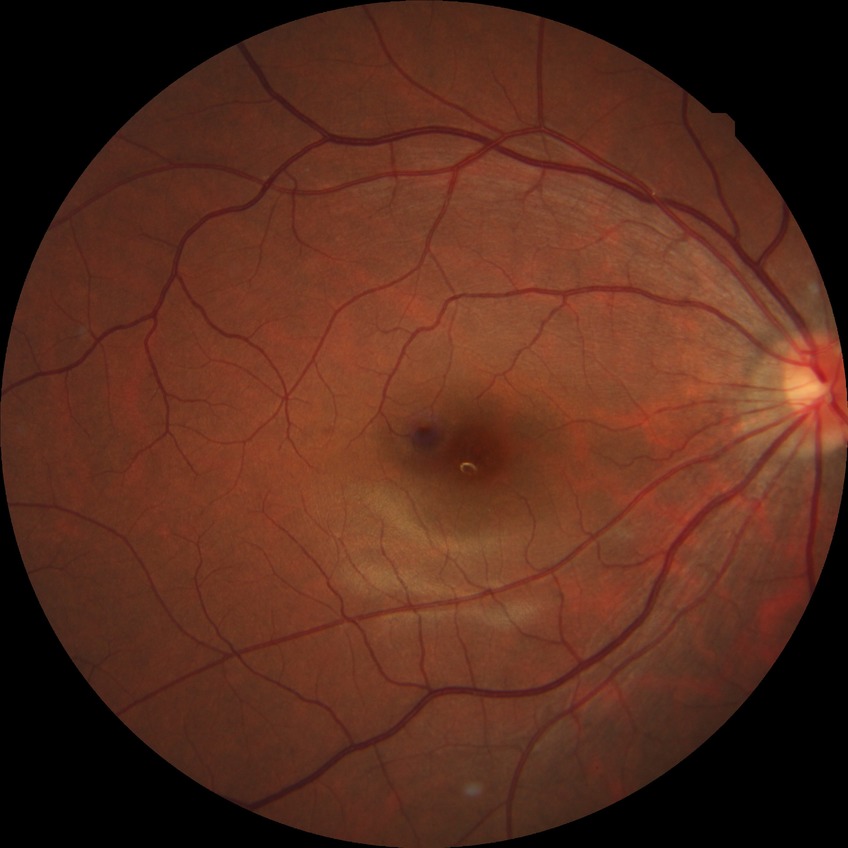 Diabetic retinopathy (DR): NDR (no diabetic retinopathy).